2352 by 1568 pixels.
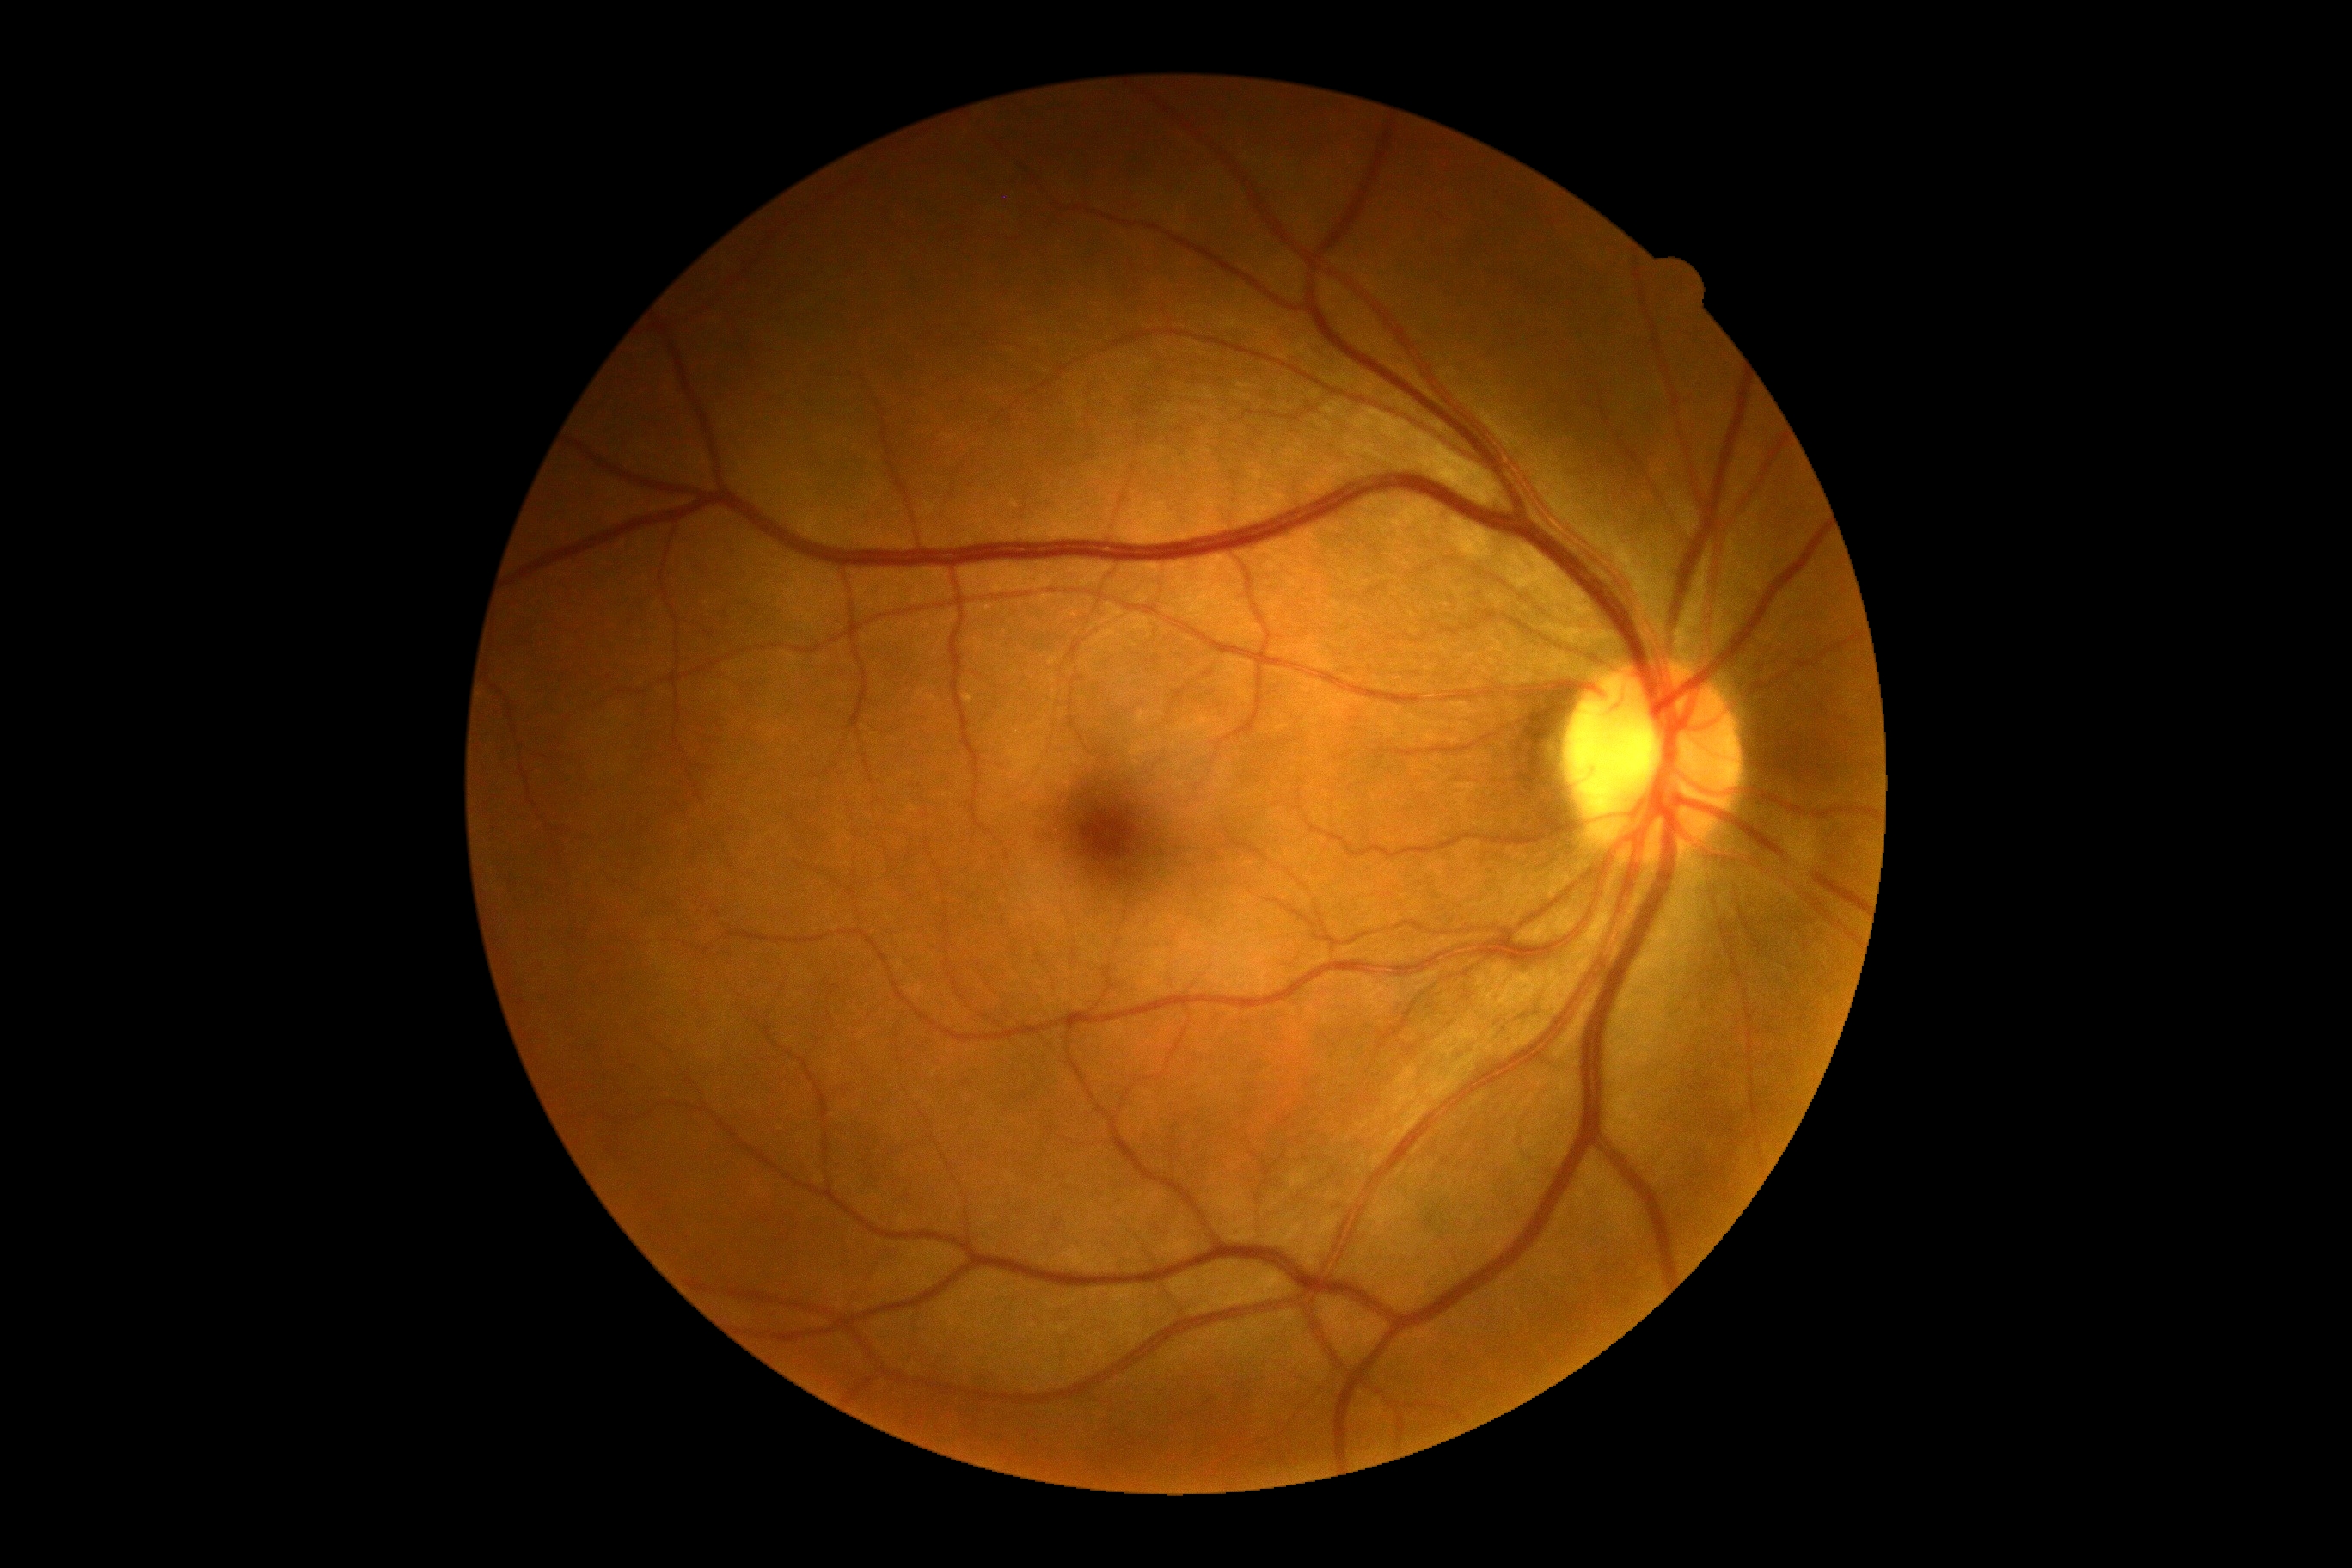

DR severity: grade 0.